1440x1080px; pediatric retinal photograph (wide-field): 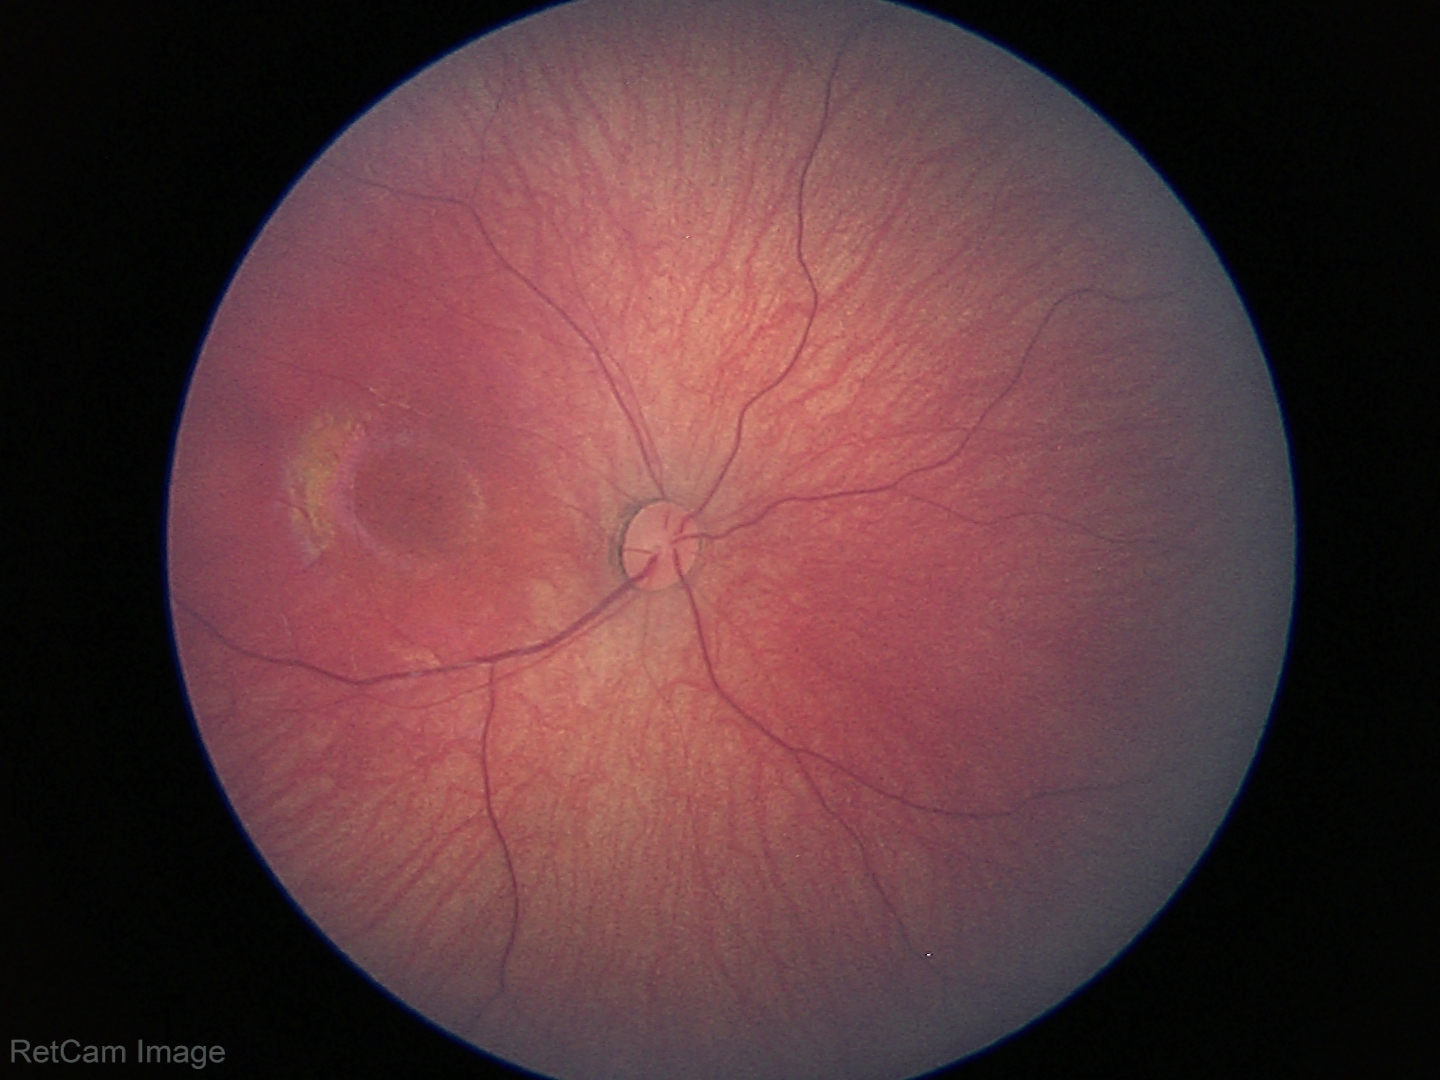 Examination with physiological retinal findings.